Acquired with a Topcon TRC-NW8; image size 1932x1932 — 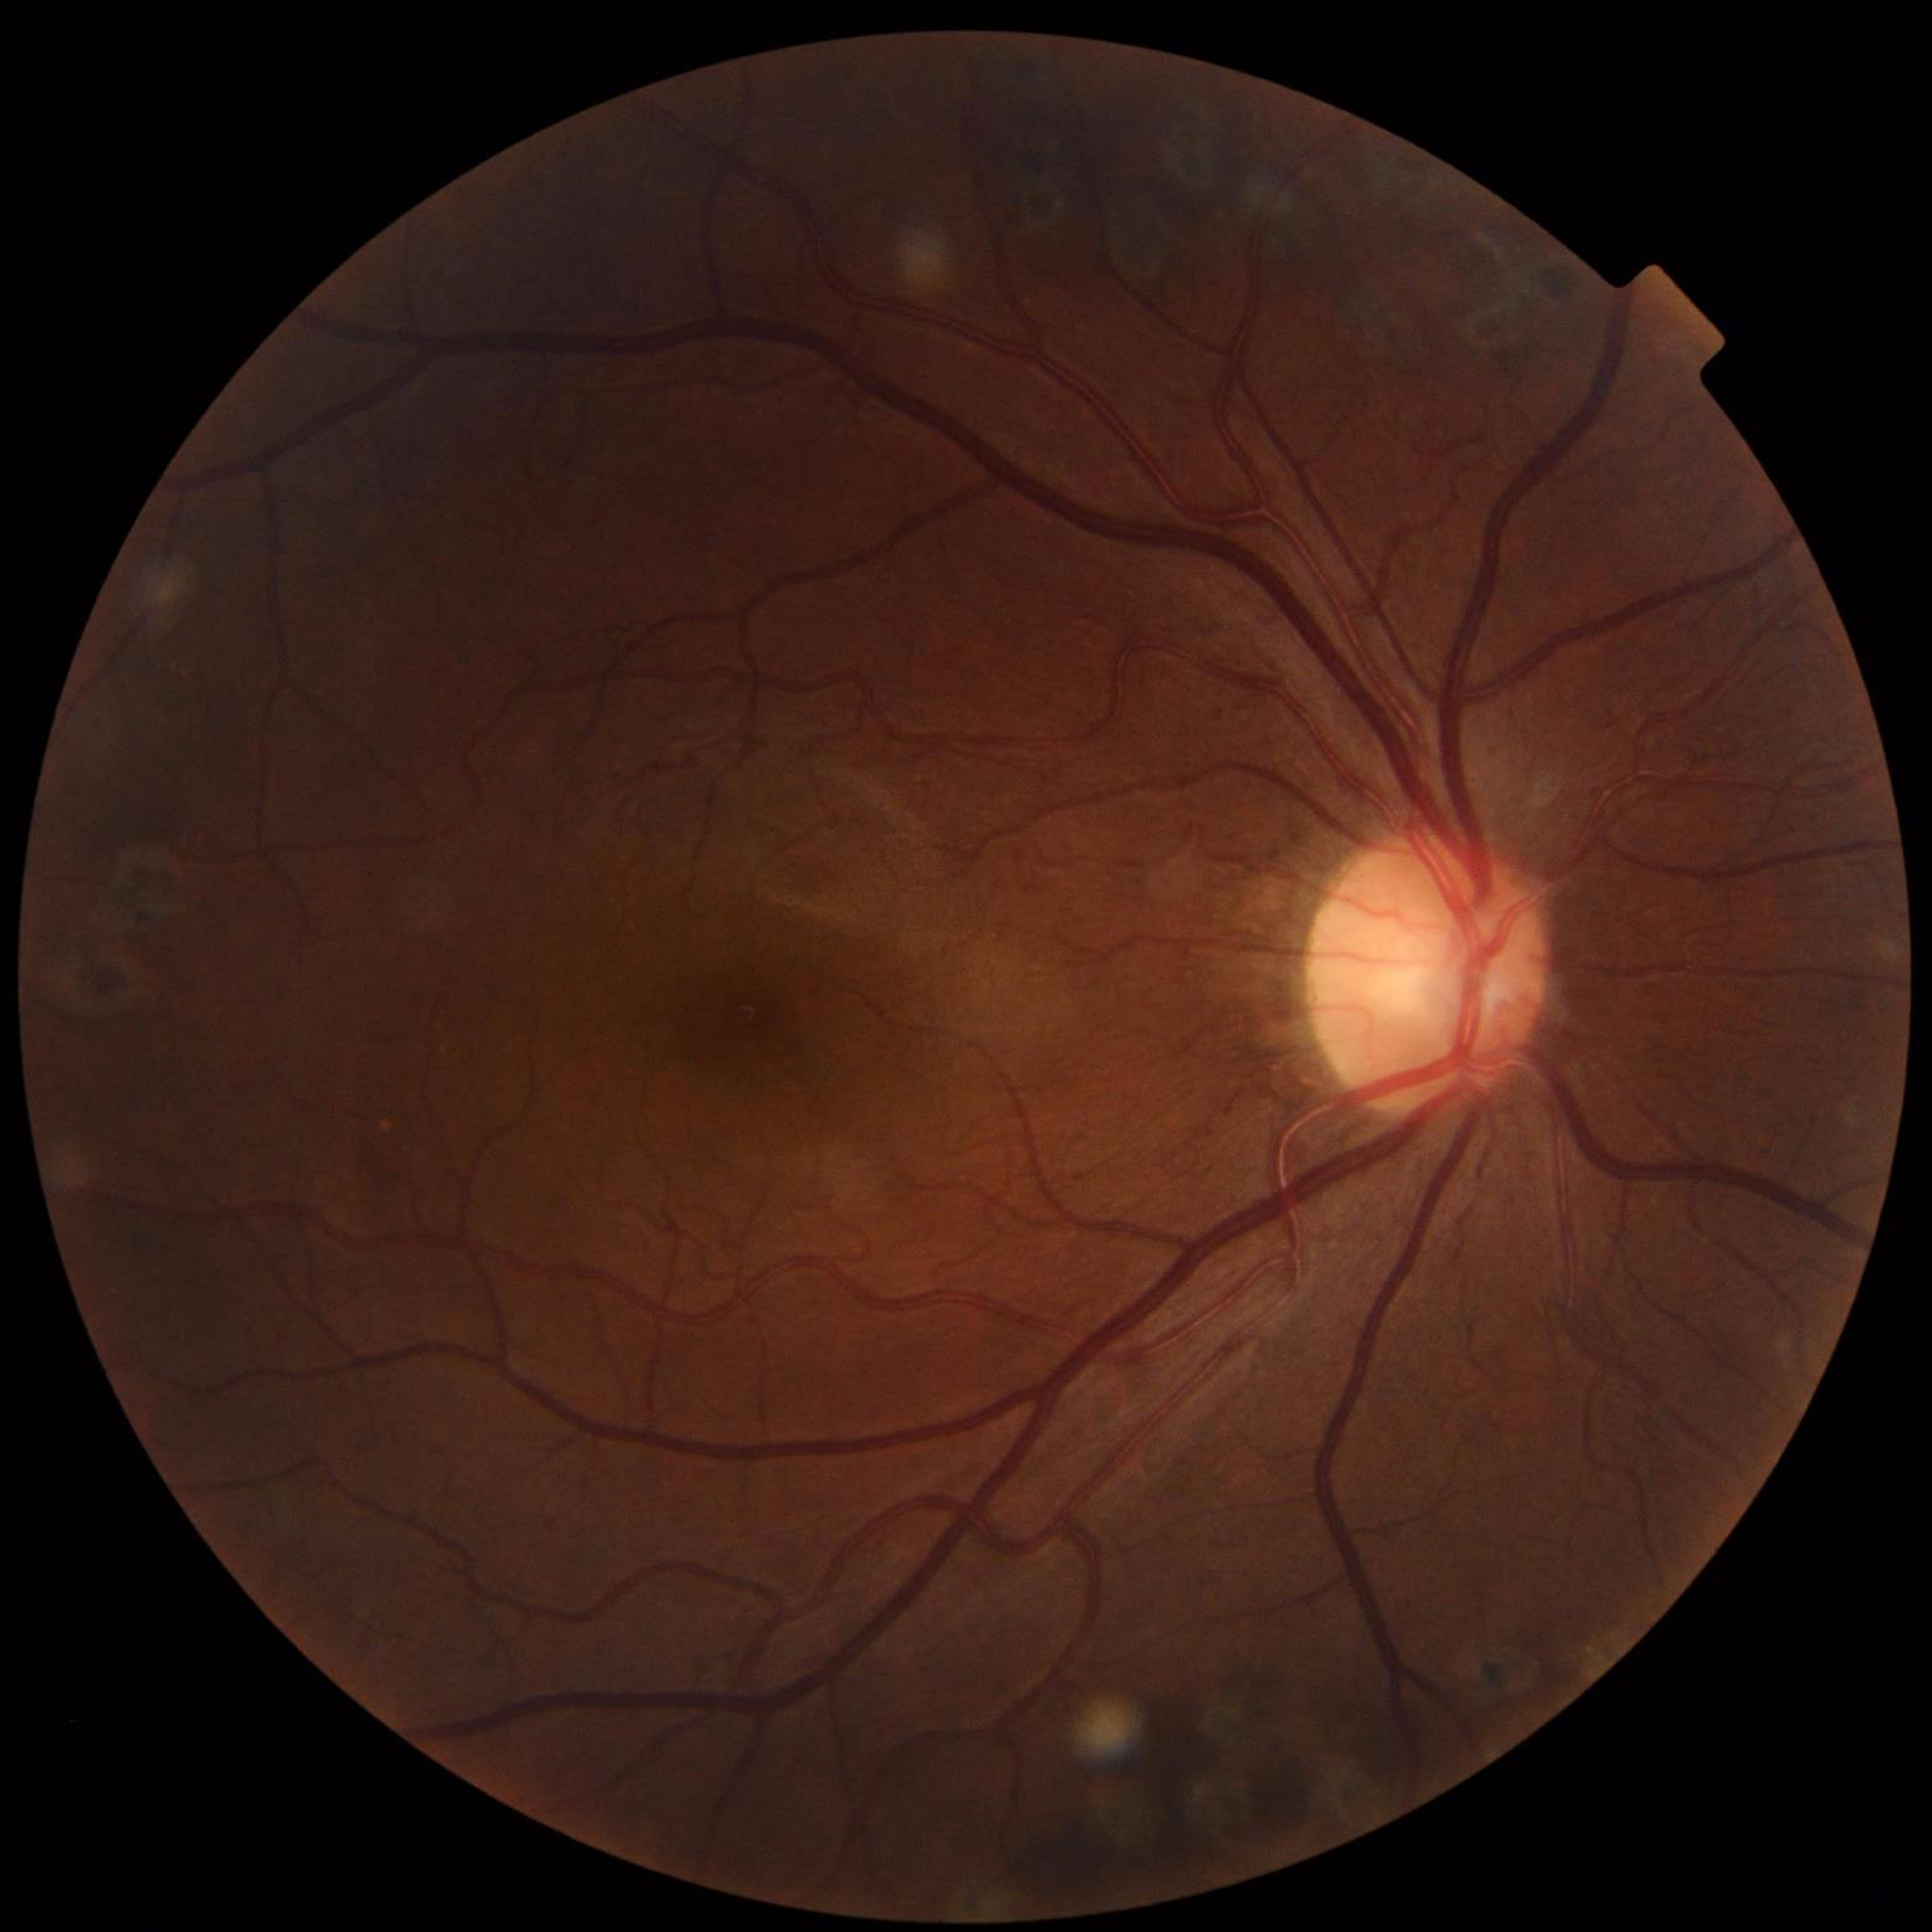

Image quality: good; Impression: diabetic retinopathy.